CFP. FOV: 45 degrees. No pharmacologic dilation
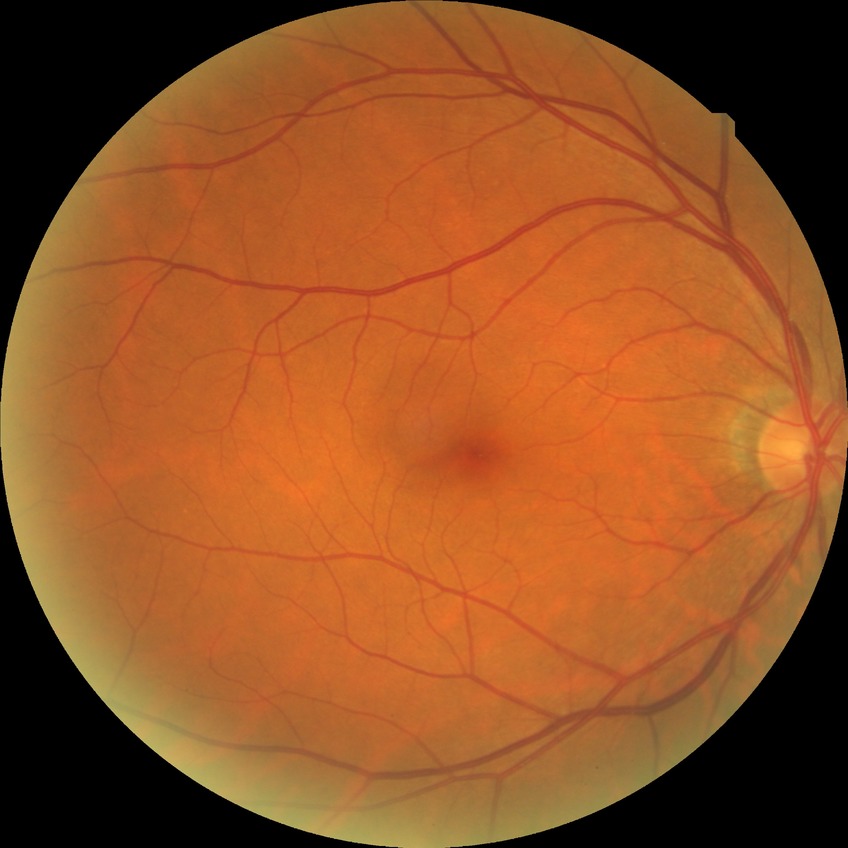 modified Davis classification: no diabetic retinopathy.